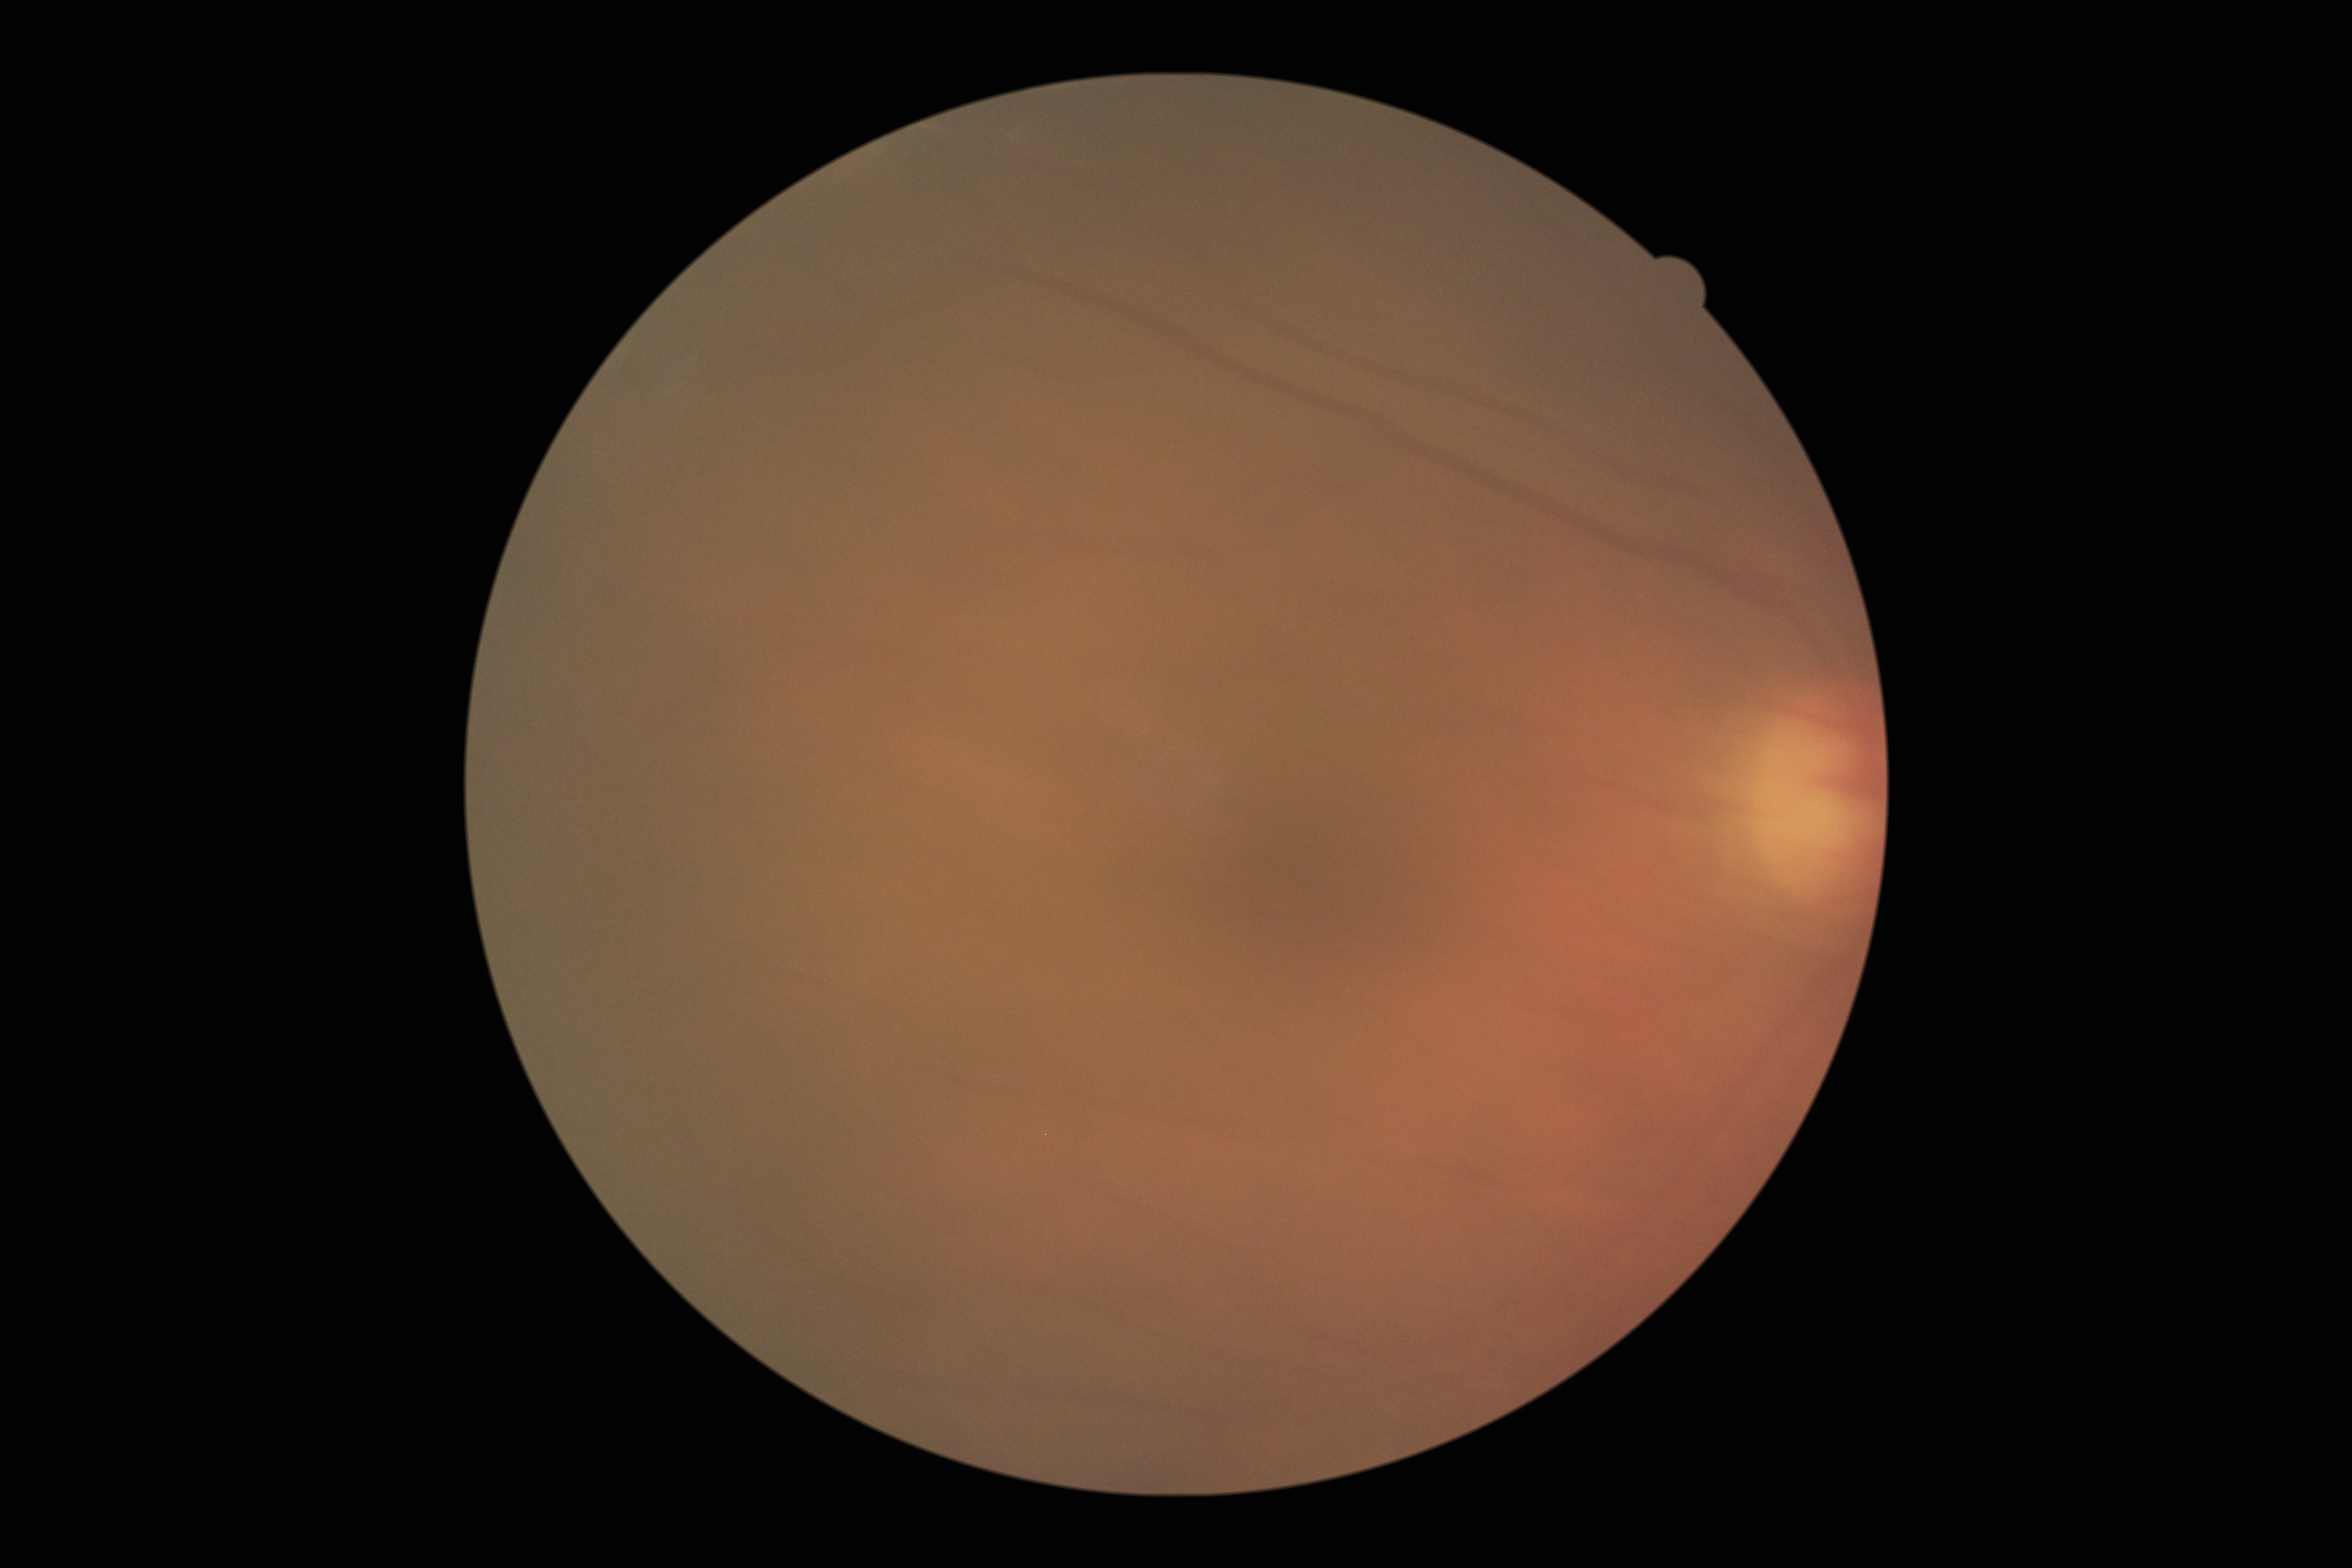

retinopathy grade@ungradable due to poor image quality.